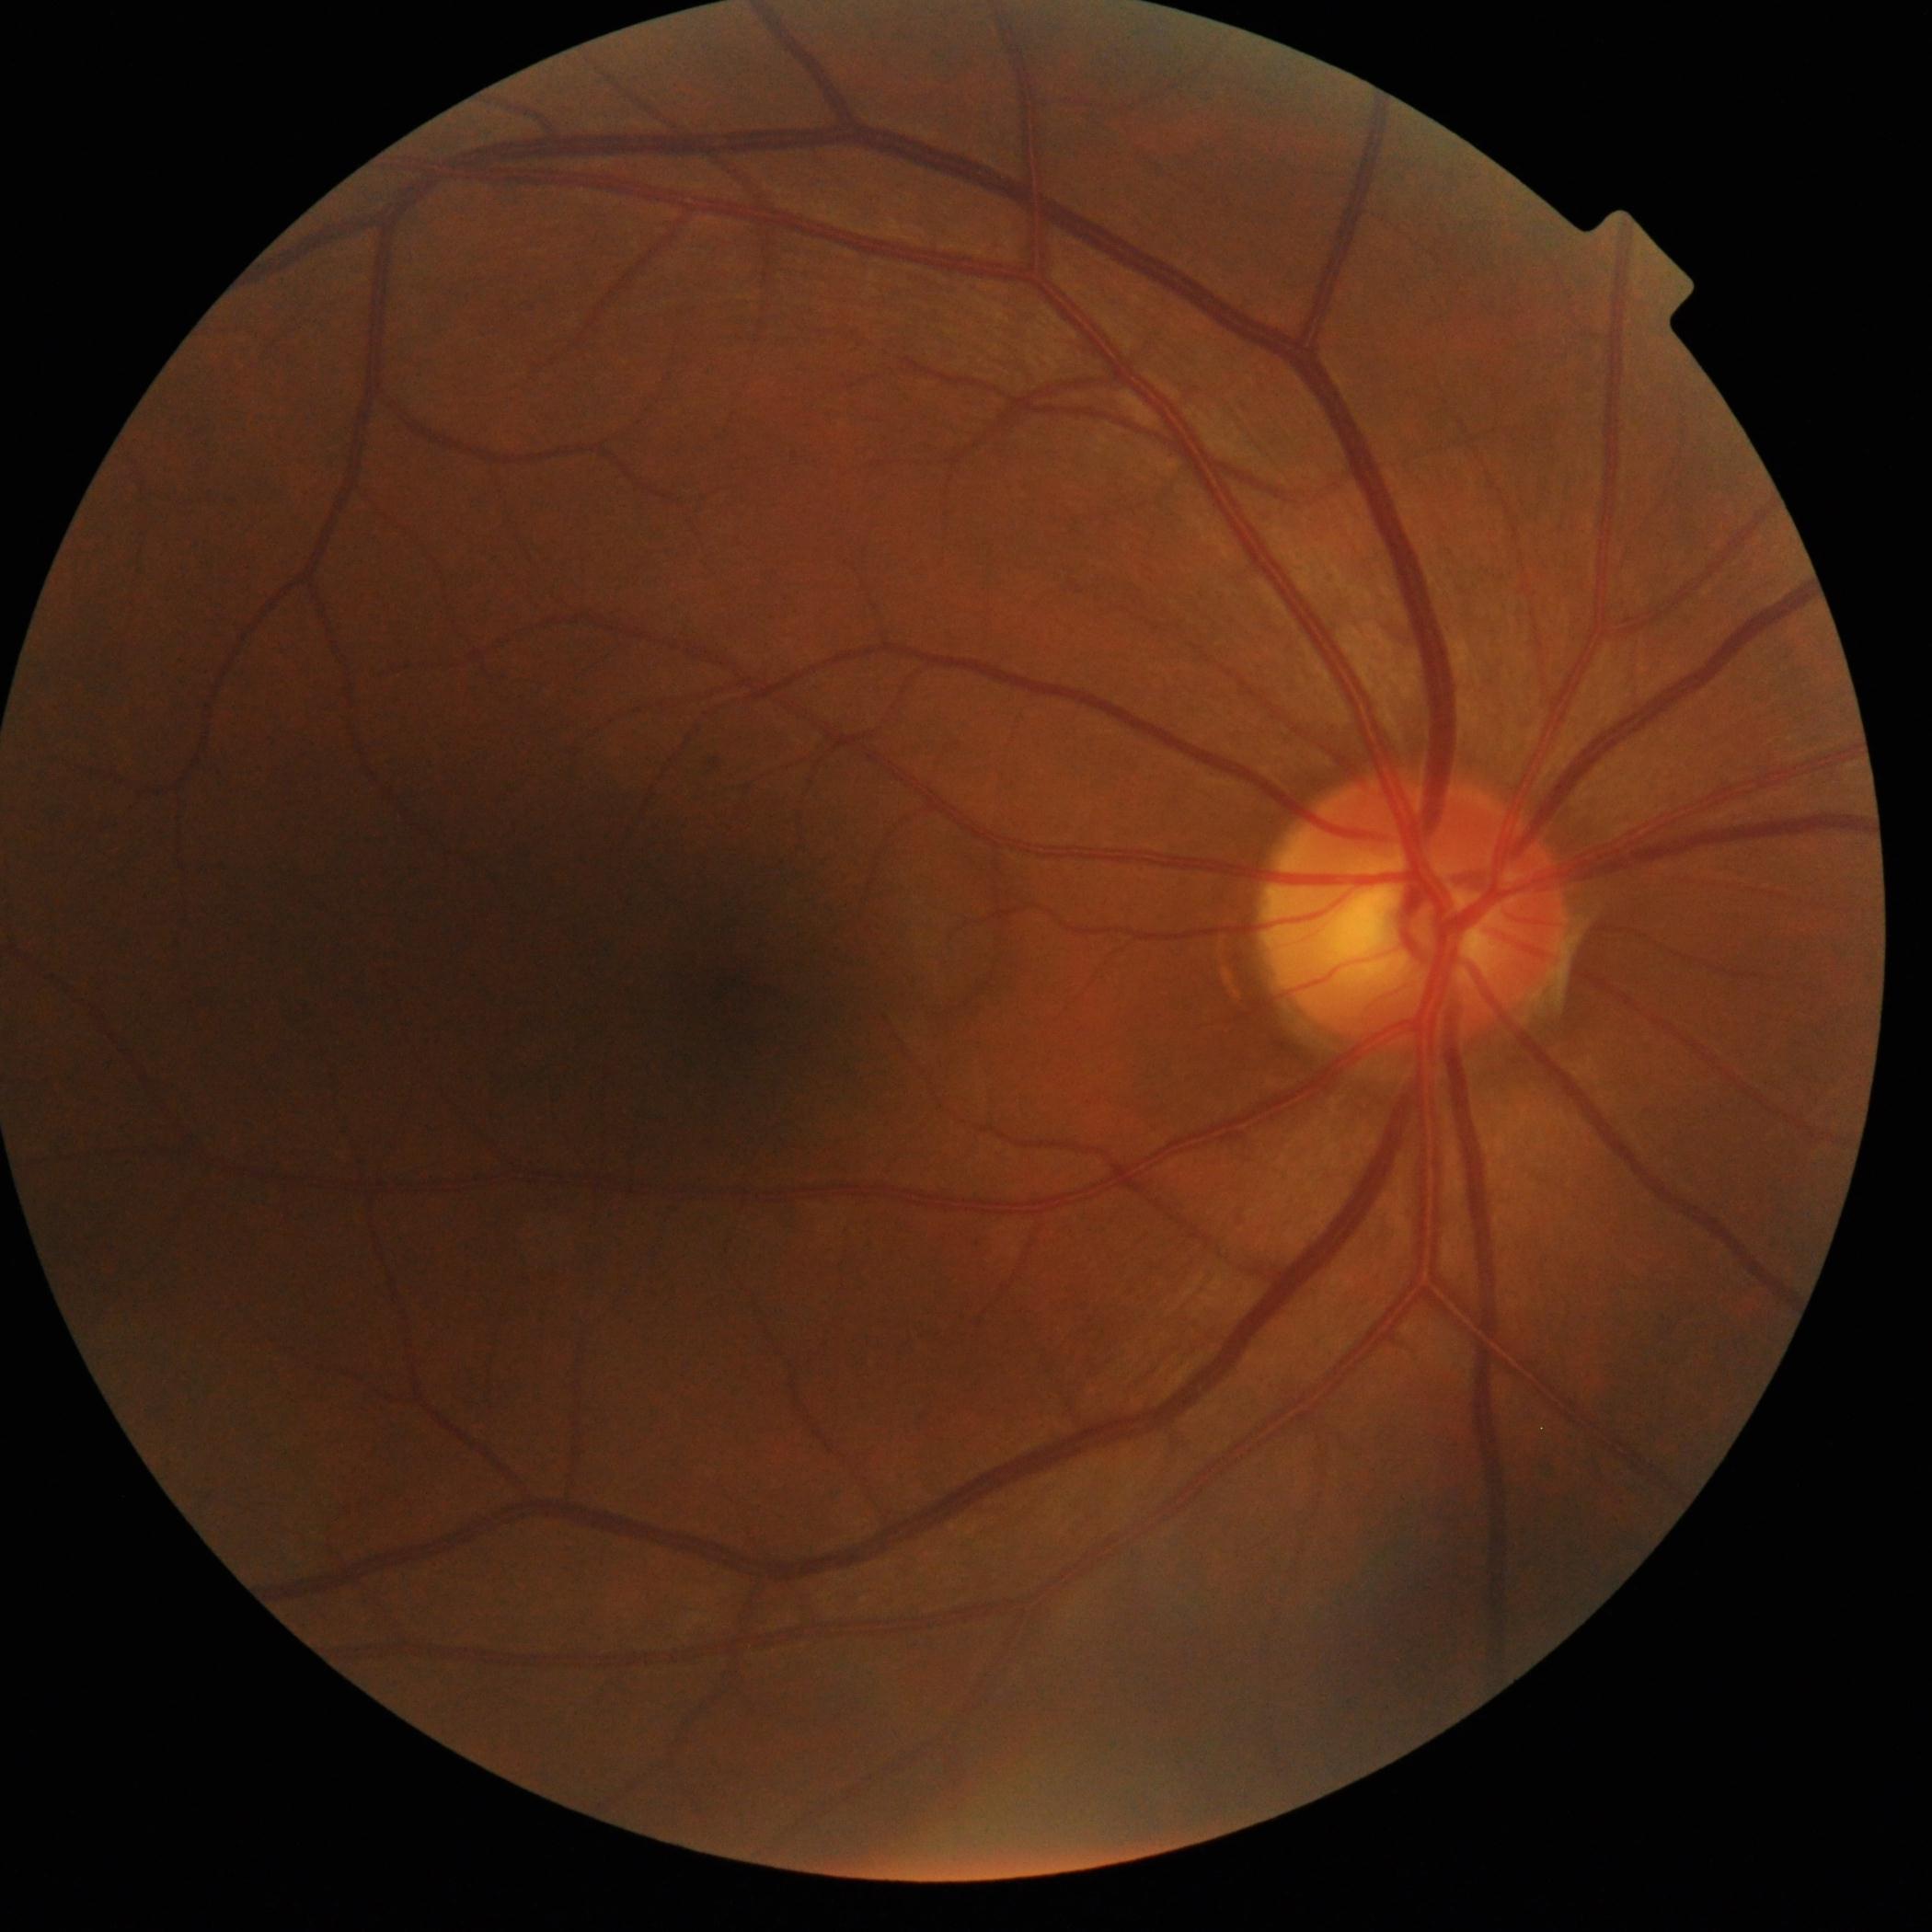
- DR impression — no DR findings
- diabetic retinopathy — grade 0